Fundus photo · image size 2352x1568: 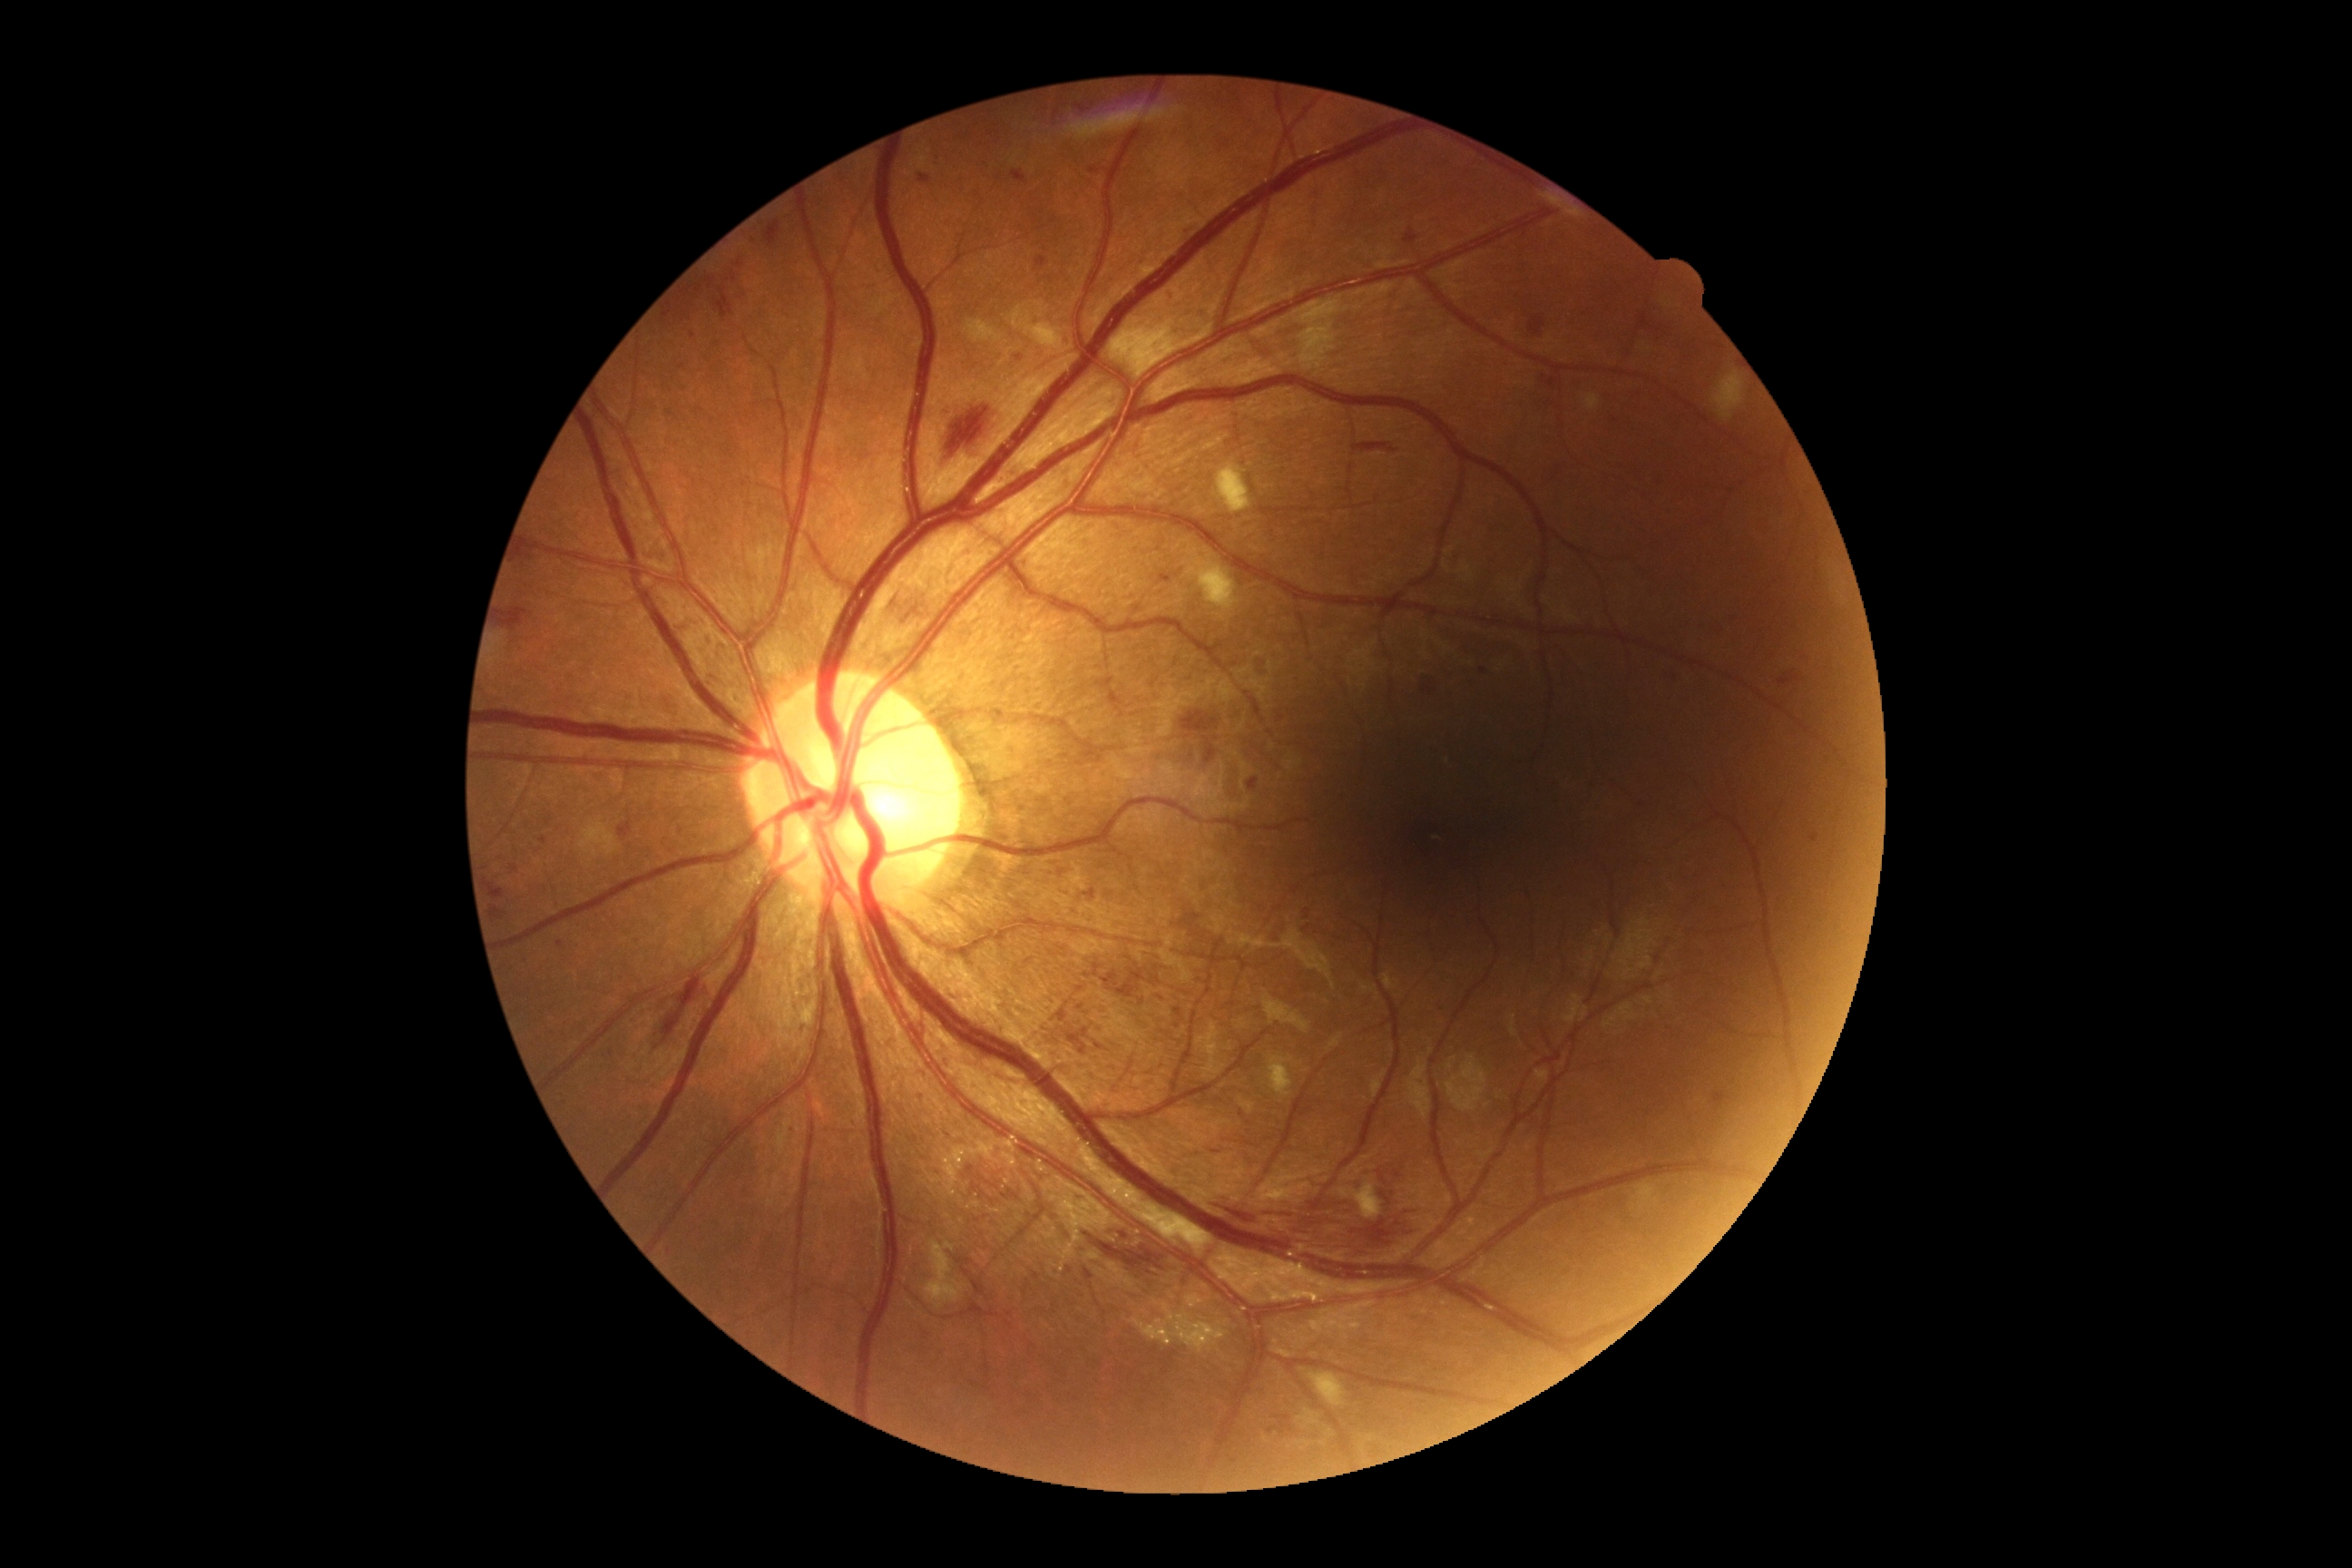

Diabetic retinopathy (DR) is 2/4.